Pediatric retinal photograph (wide-field). 1240x1240.
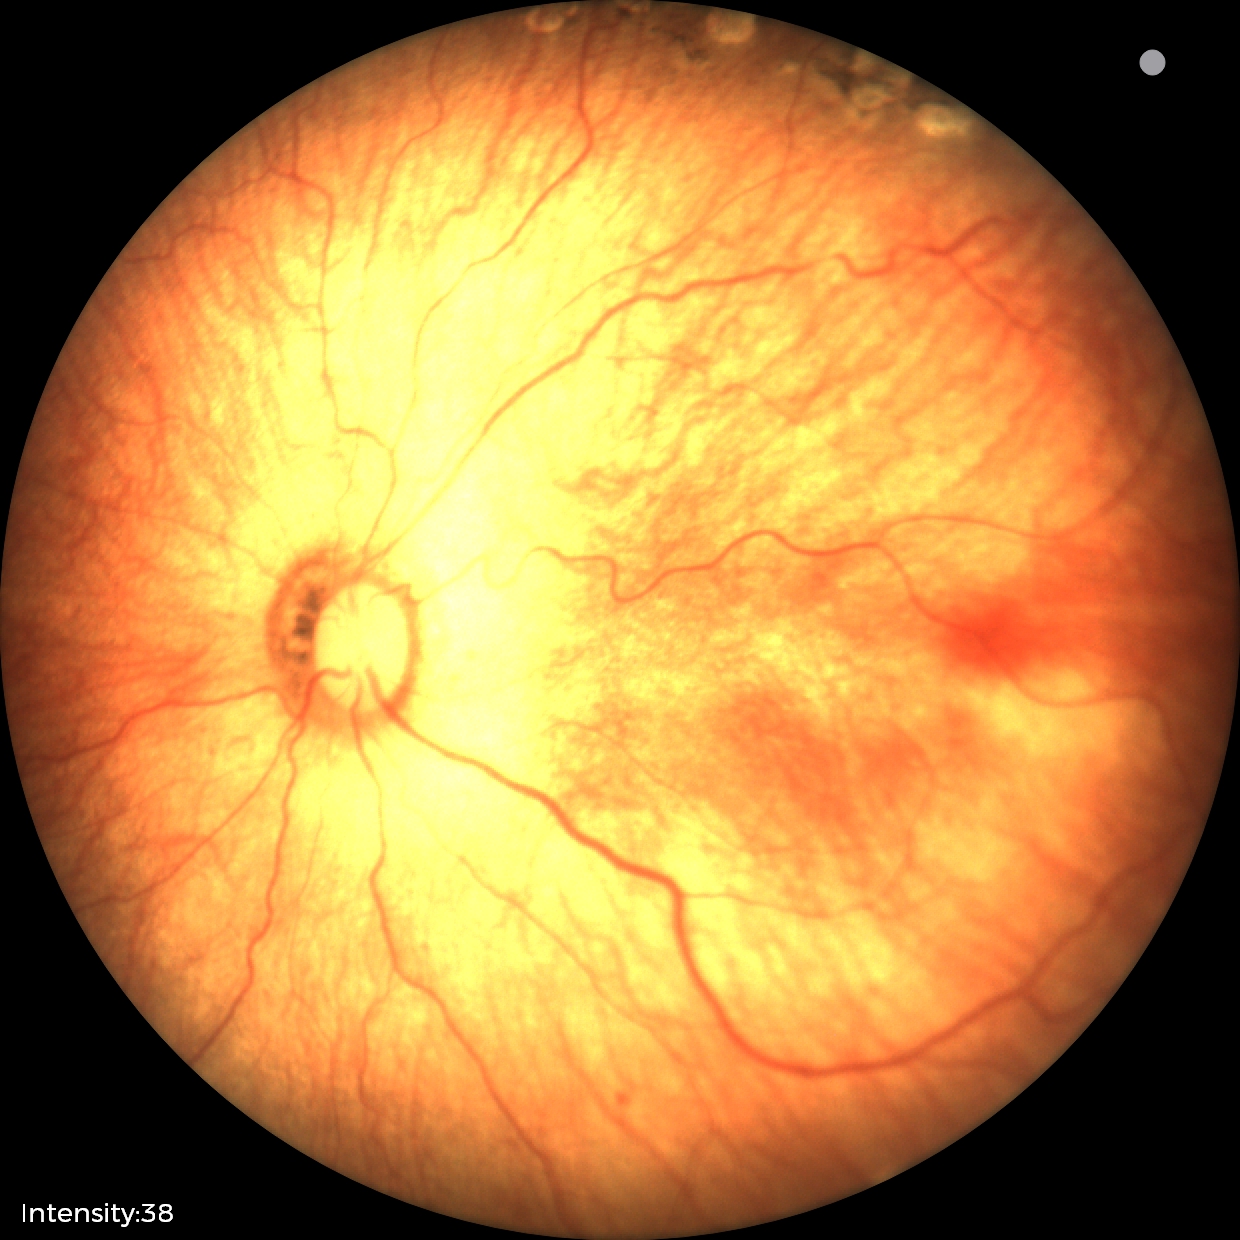 Assessment: status post retinopathy of prematurity — retinal appearance after treated retinopathy of prematurity | no plus disease.